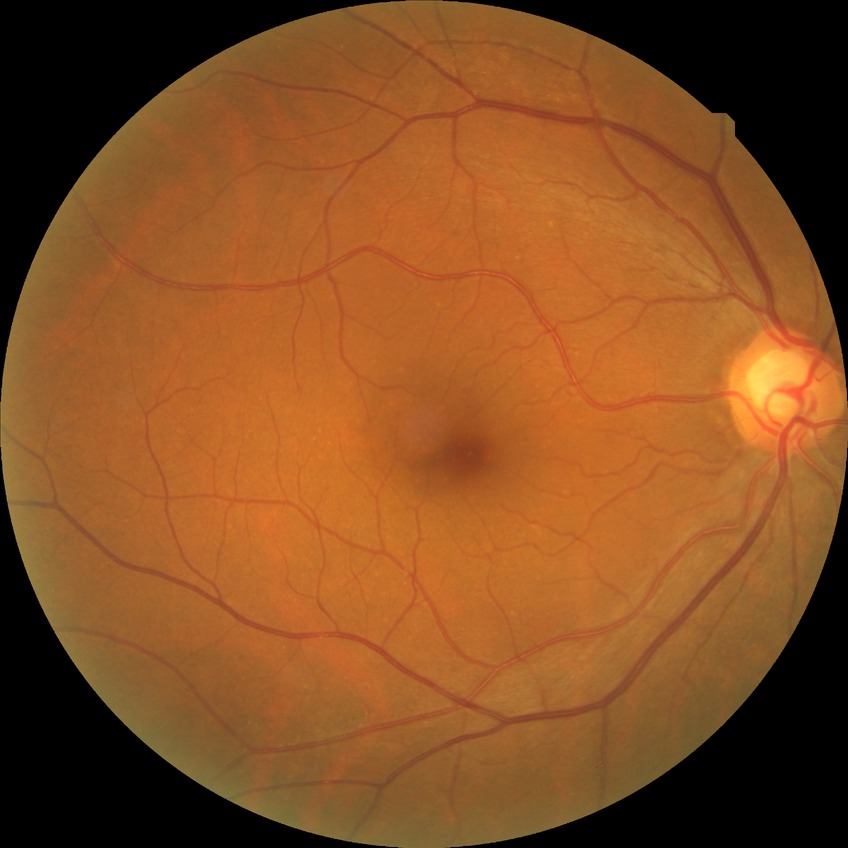
No apparent diabetic retinopathy. Davis grade: NDR.